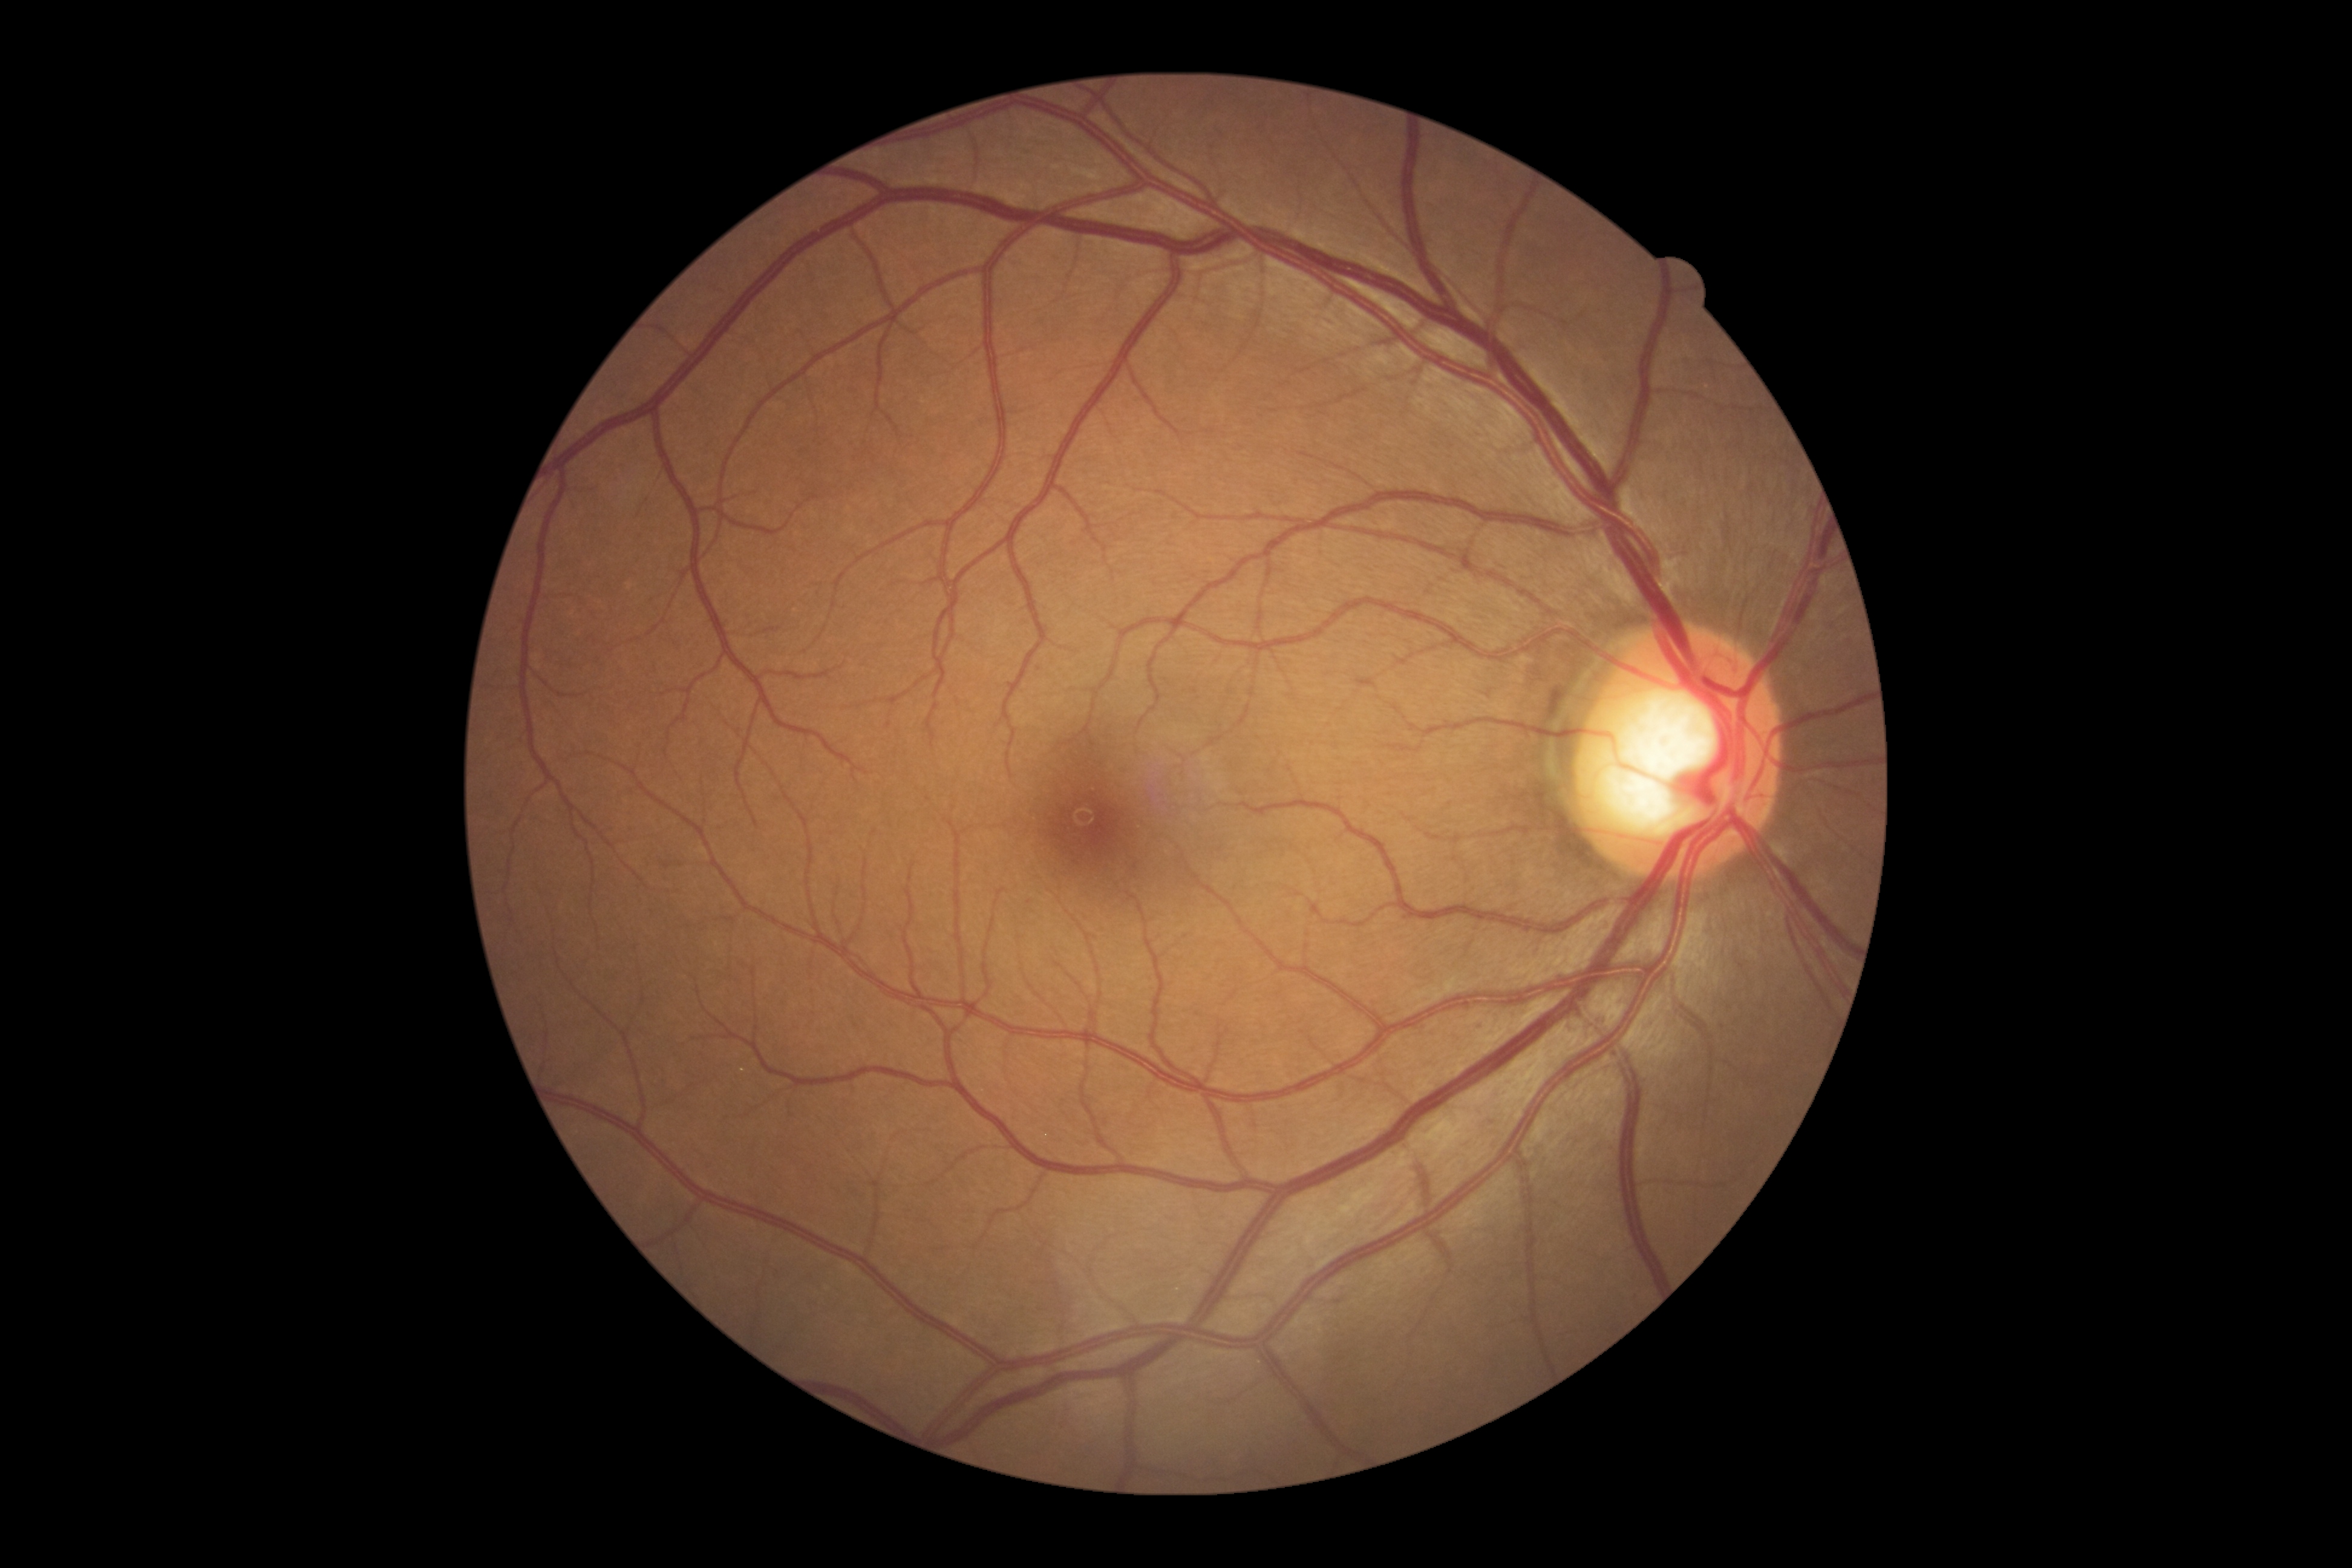

DR stage: grade 0 (no apparent retinopathy).